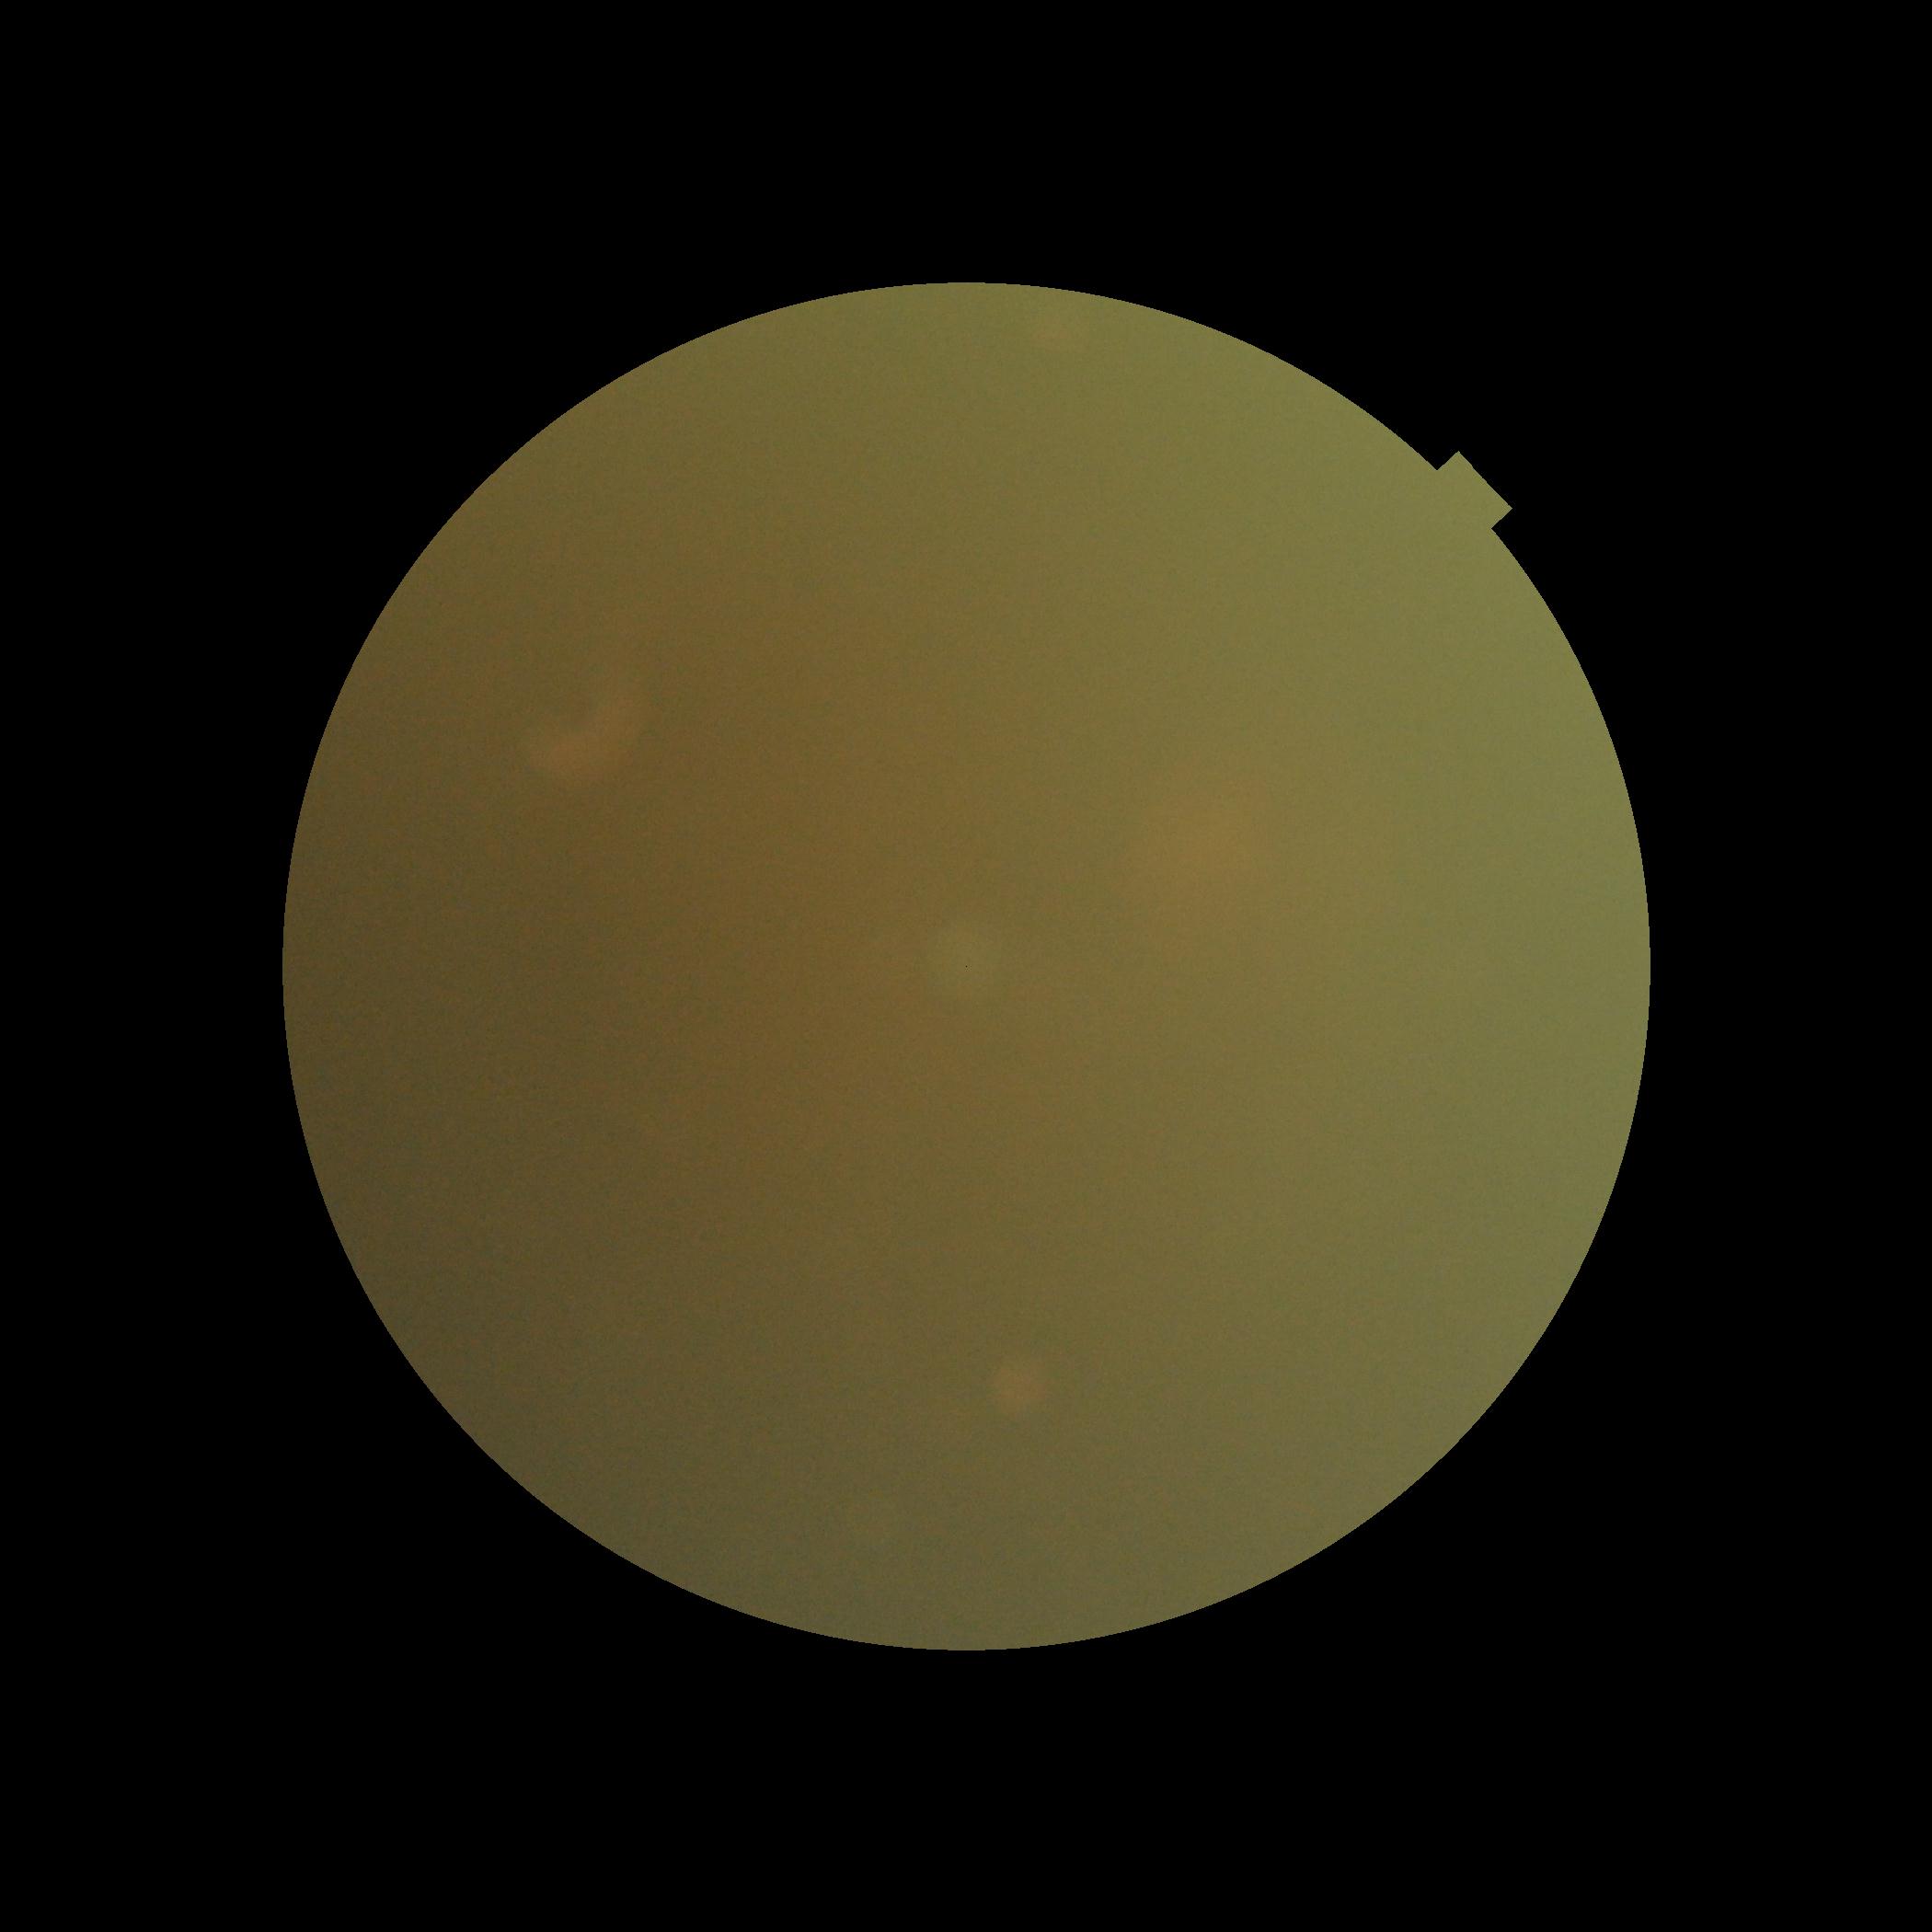

image quality = insufficient for DR assessment, DR severity = ungradable due to poor image quality.